Retinal fundus photograph · 45-degree field of view · 1932 x 1910 pixels: 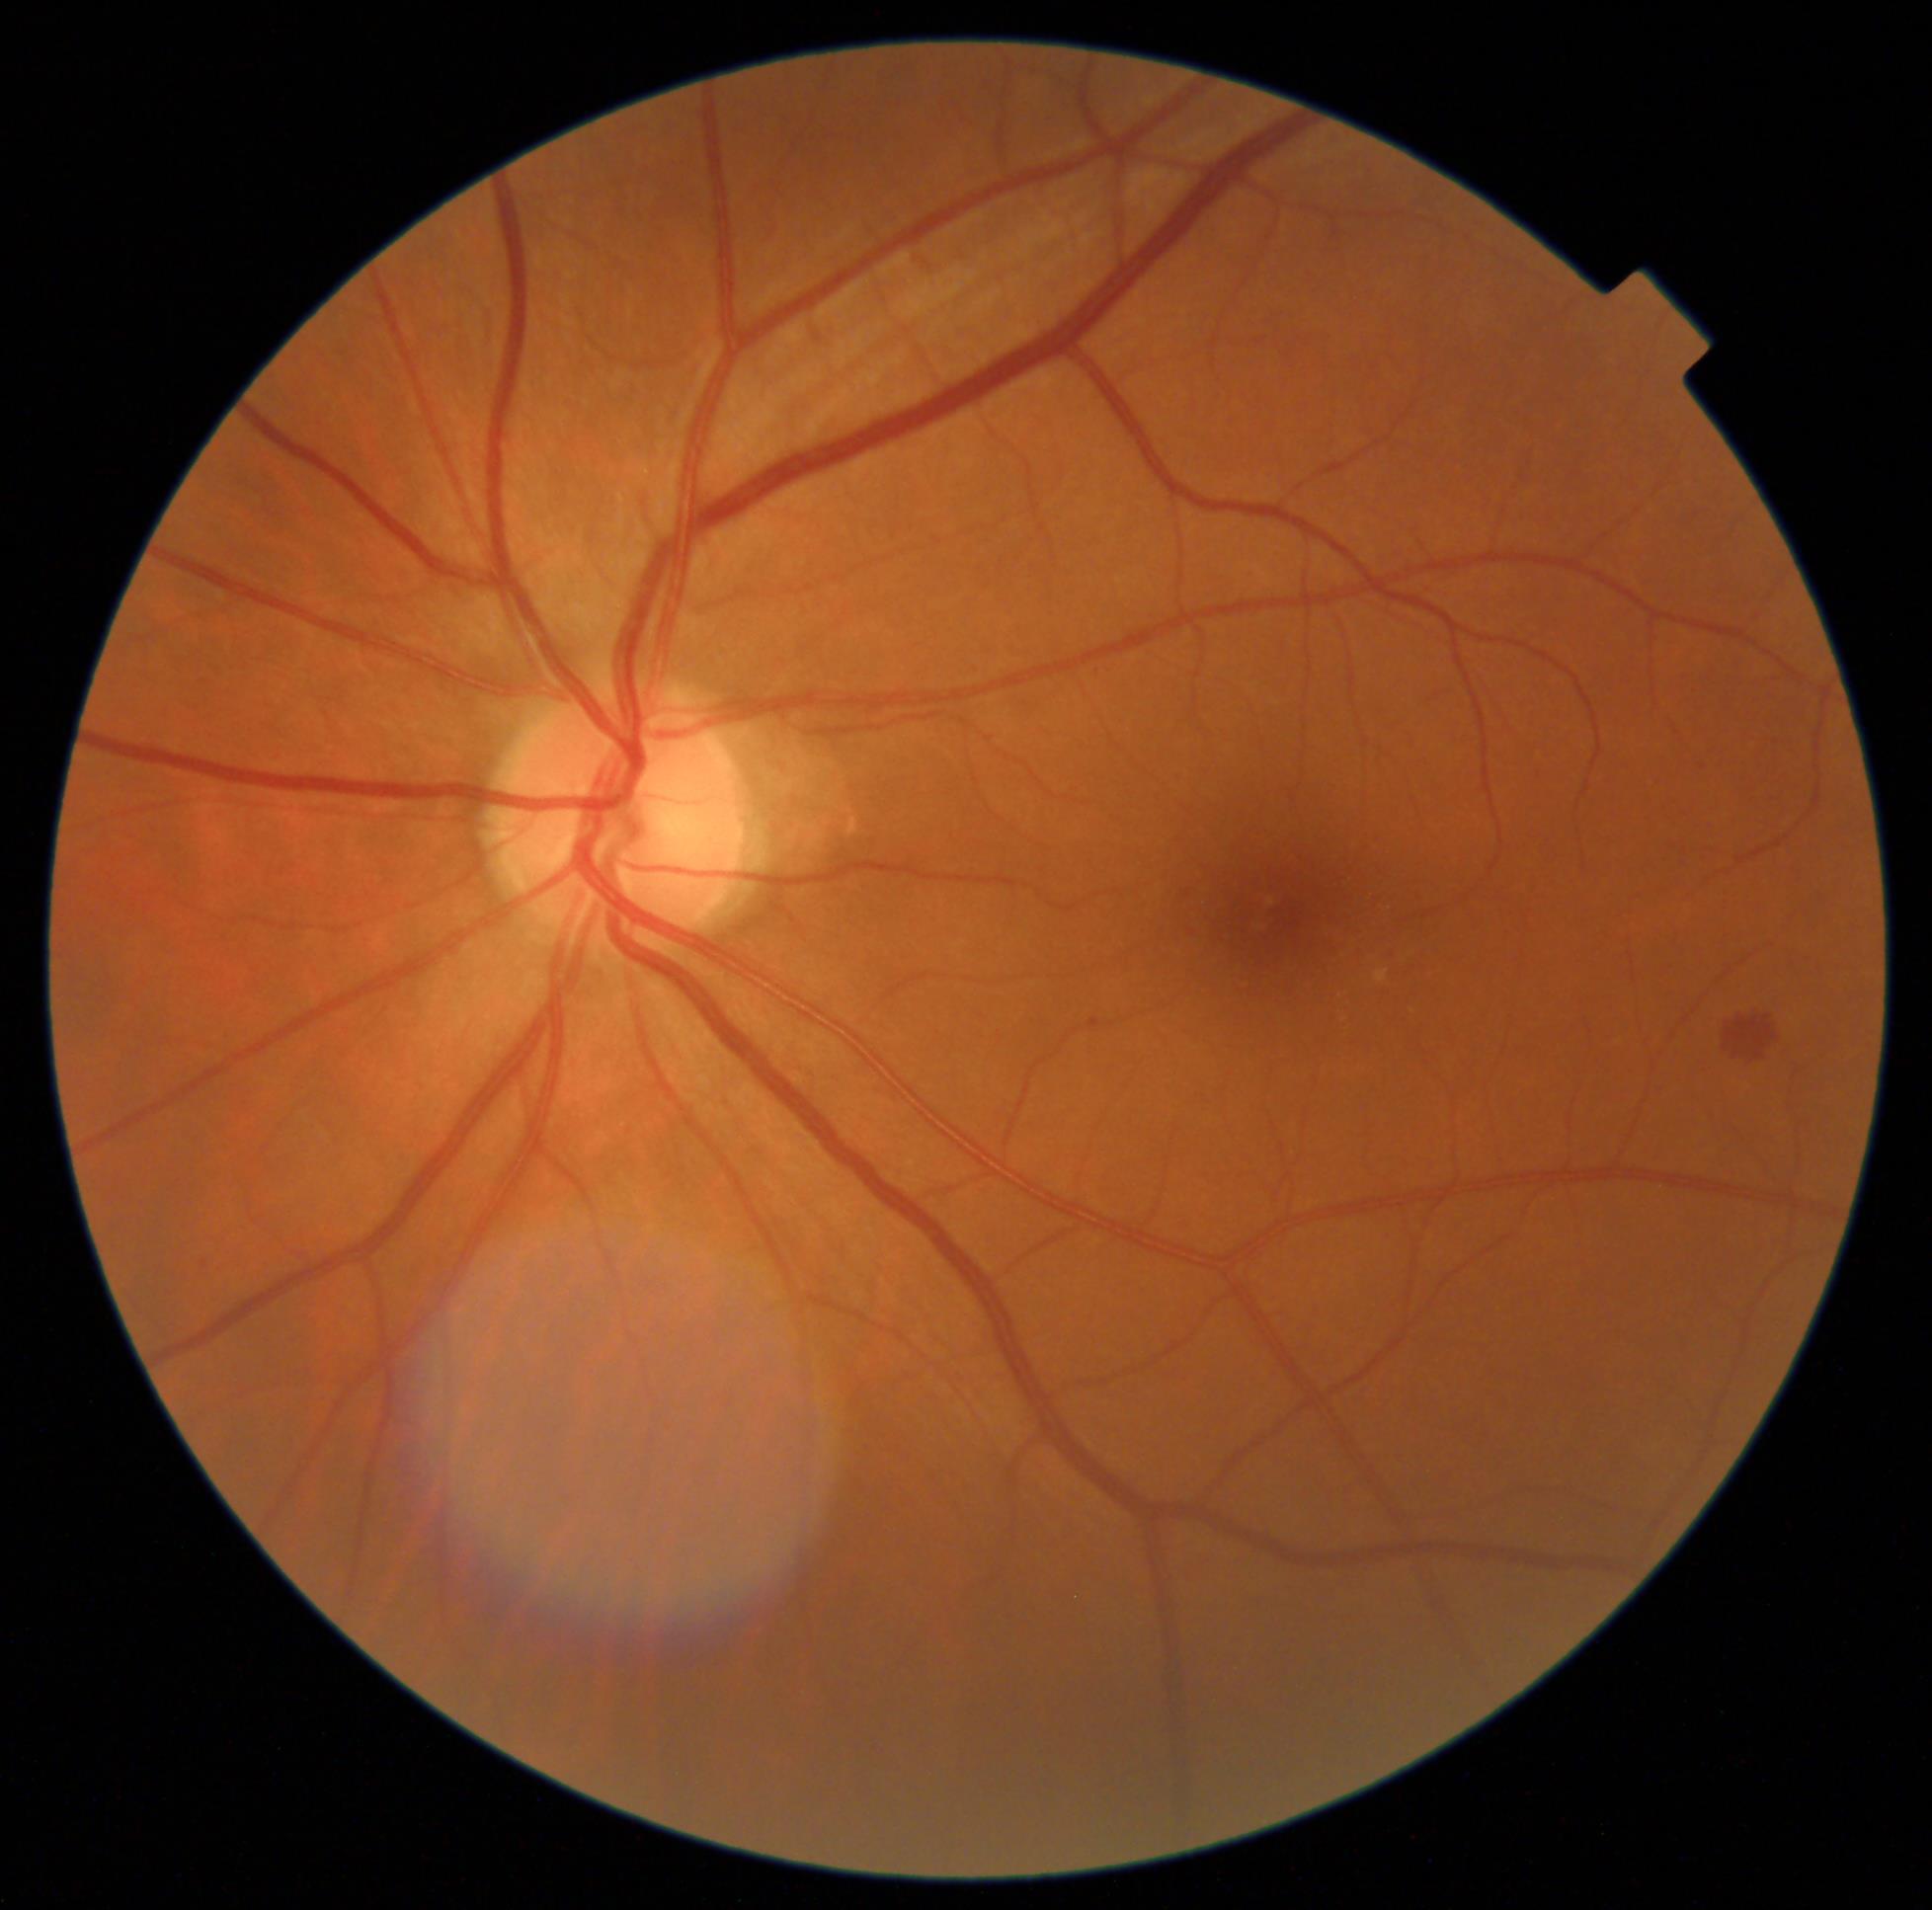 DR severity: grade 2.